Phoenix ICON wide-field infant fundus image; 1240 x 1240 pixels; camera: Phoenix ICON (100° FOV):
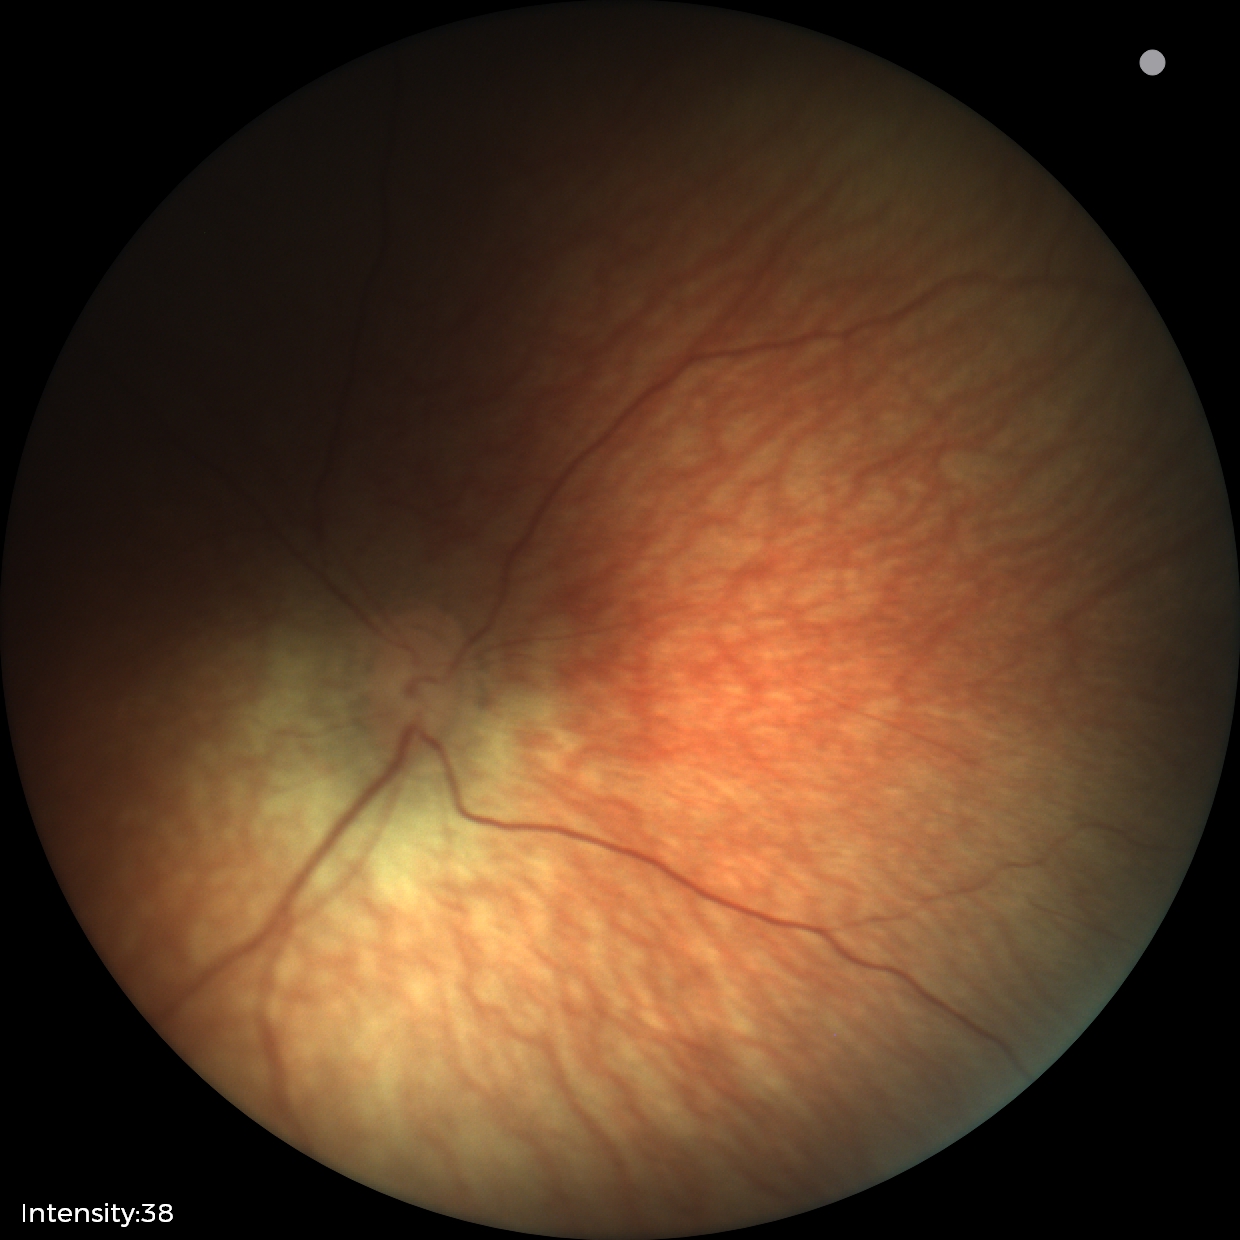 Screening: no abnormal retinal findings.